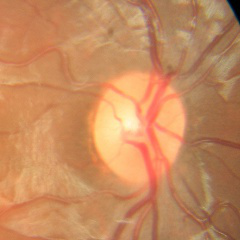
This fundus photograph shows no glaucoma.